Infant wide-field fundus photograph — 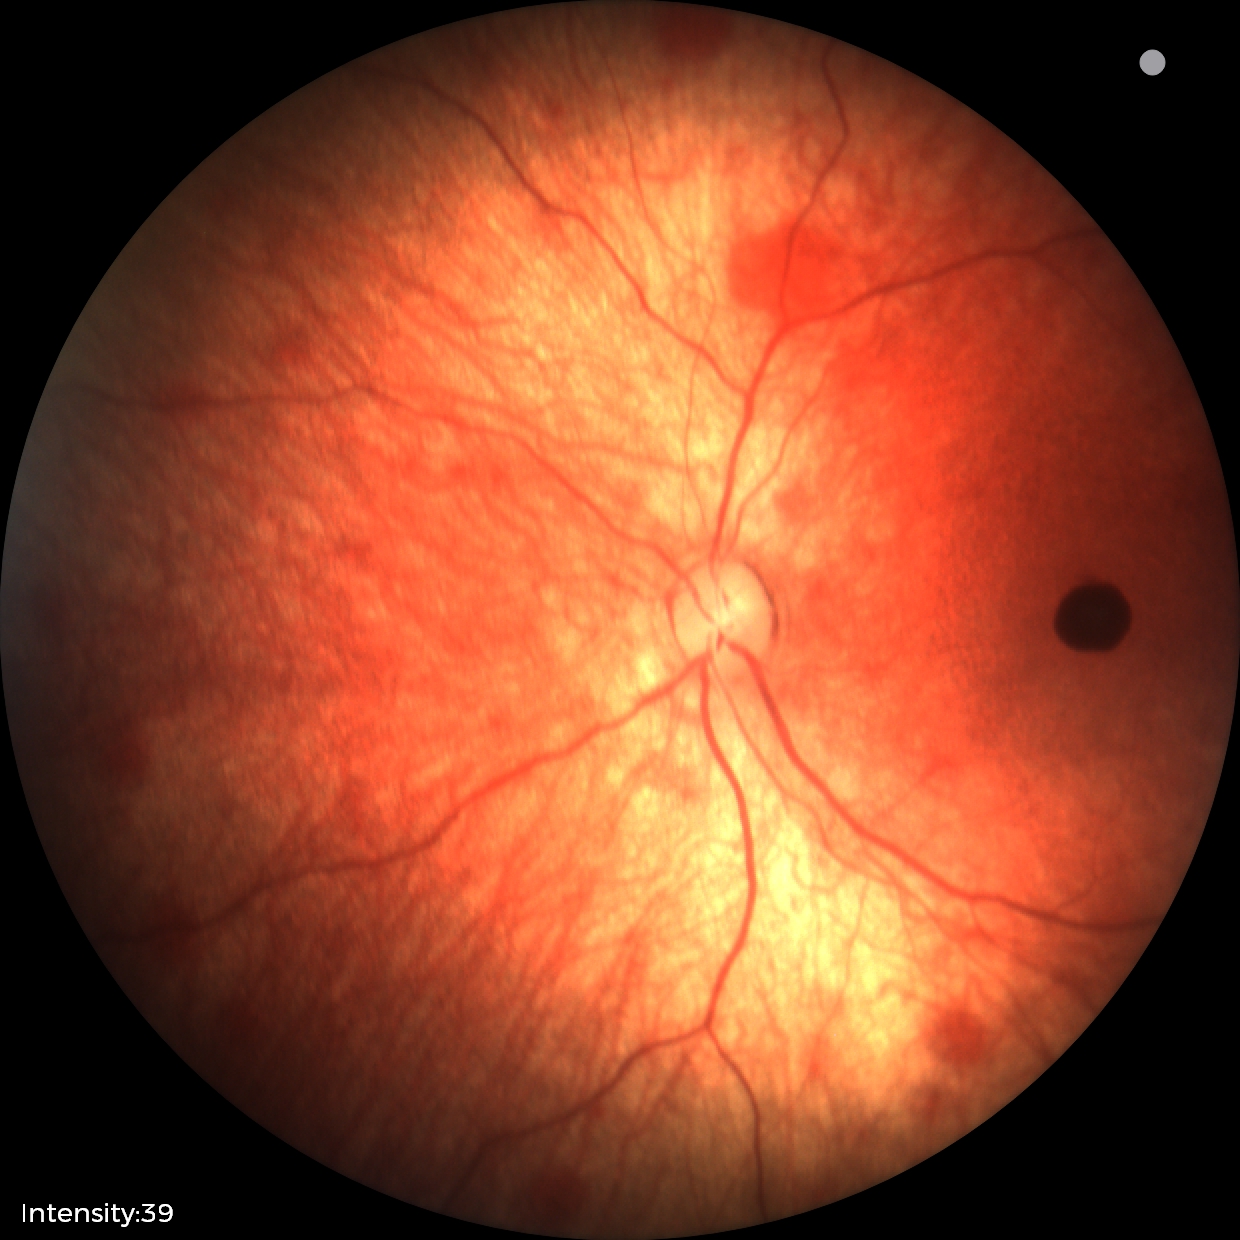

Examination diagnosed as retinal hemorrhages.